Color fundus photograph — 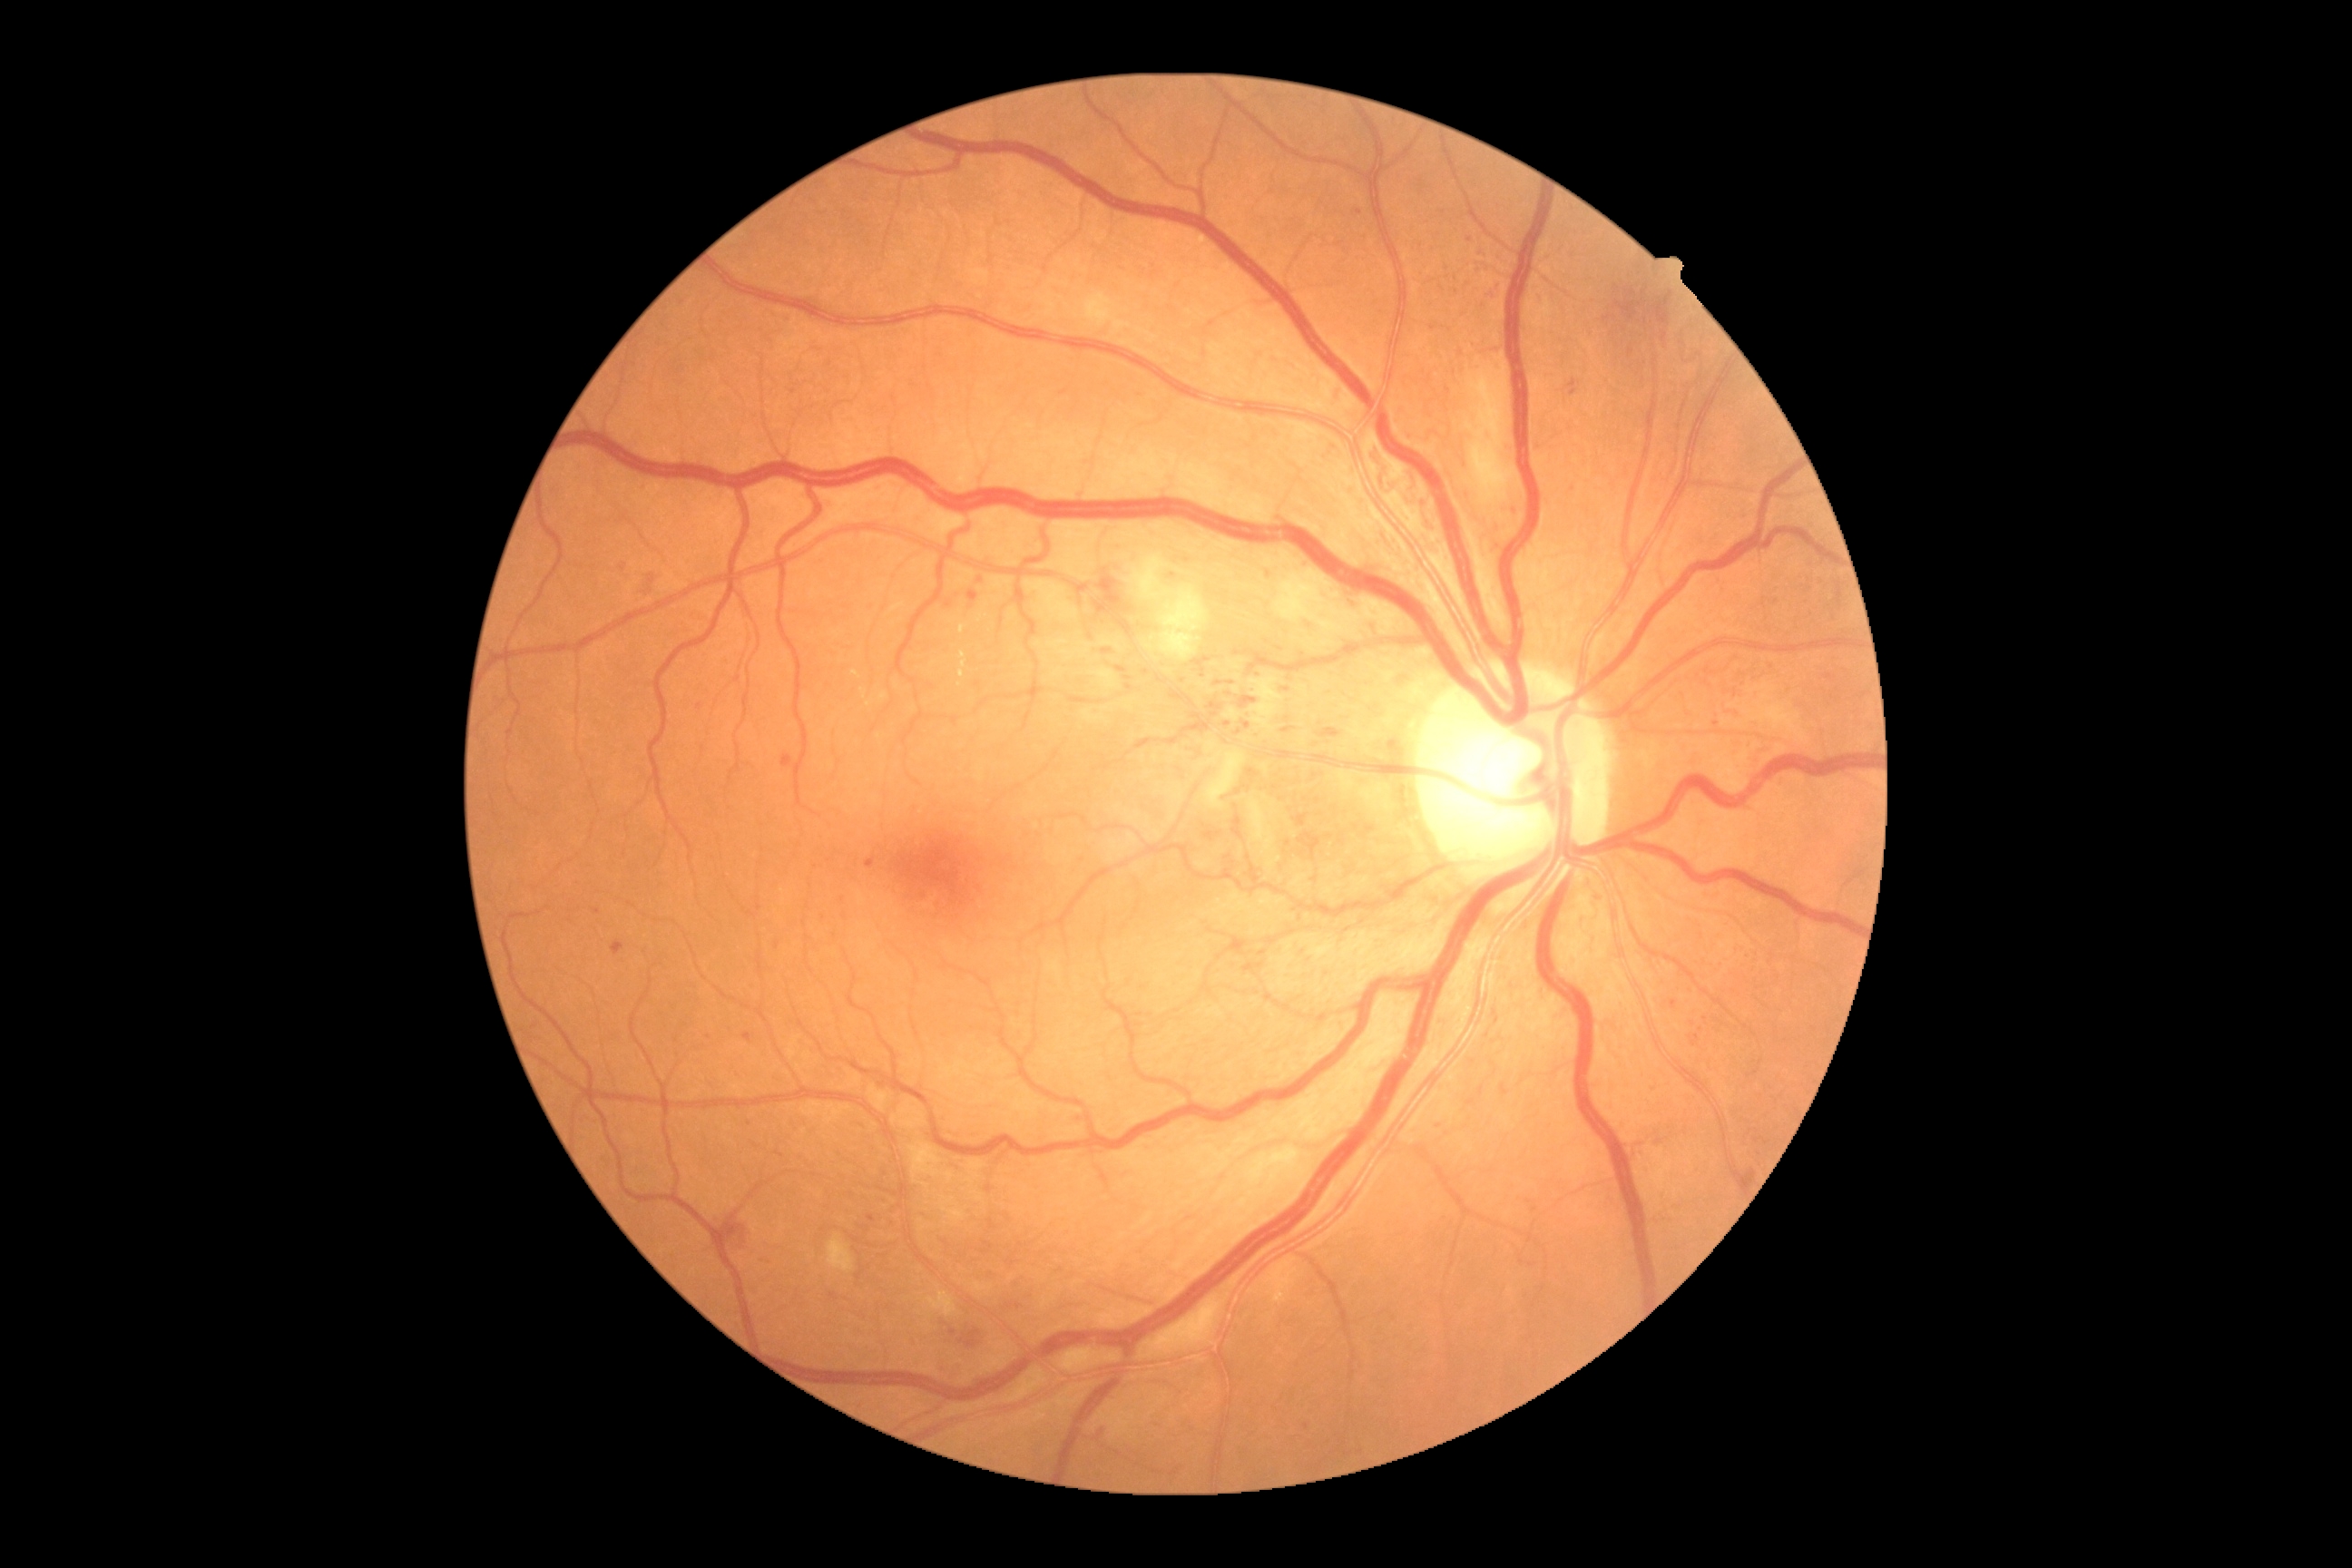

Retinopathy grade: 3 — more than 20 intraretinal hemorrhages in each of 4 quadrants, definite venous beading in 2 or more quadrants, or prominent intraretinal microvascular abnormalities in 1 or more quadrants, with no signs of proliferative retinopathy. DR class: non-proliferative diabetic retinopathy.